Pediatric retinal photograph (wide-field); 640x480px; camera: Clarity RetCam 3 (130° FOV):
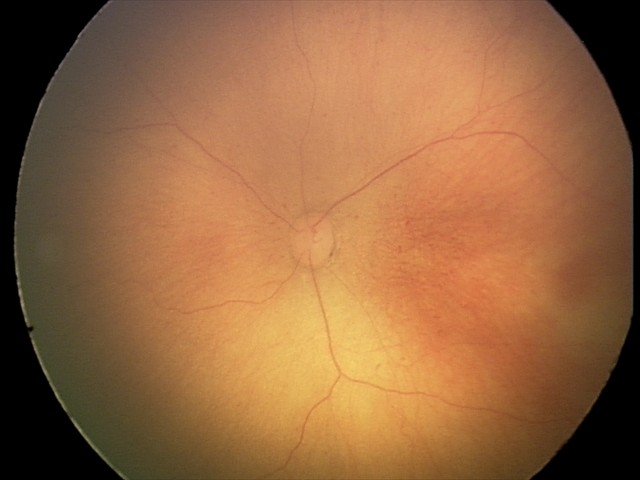

No plus disease. From an examination with diagnosis of retinopathy of prematurity stage 0 — incomplete retinal vascularization without a demarcation line.